1932x1910px: 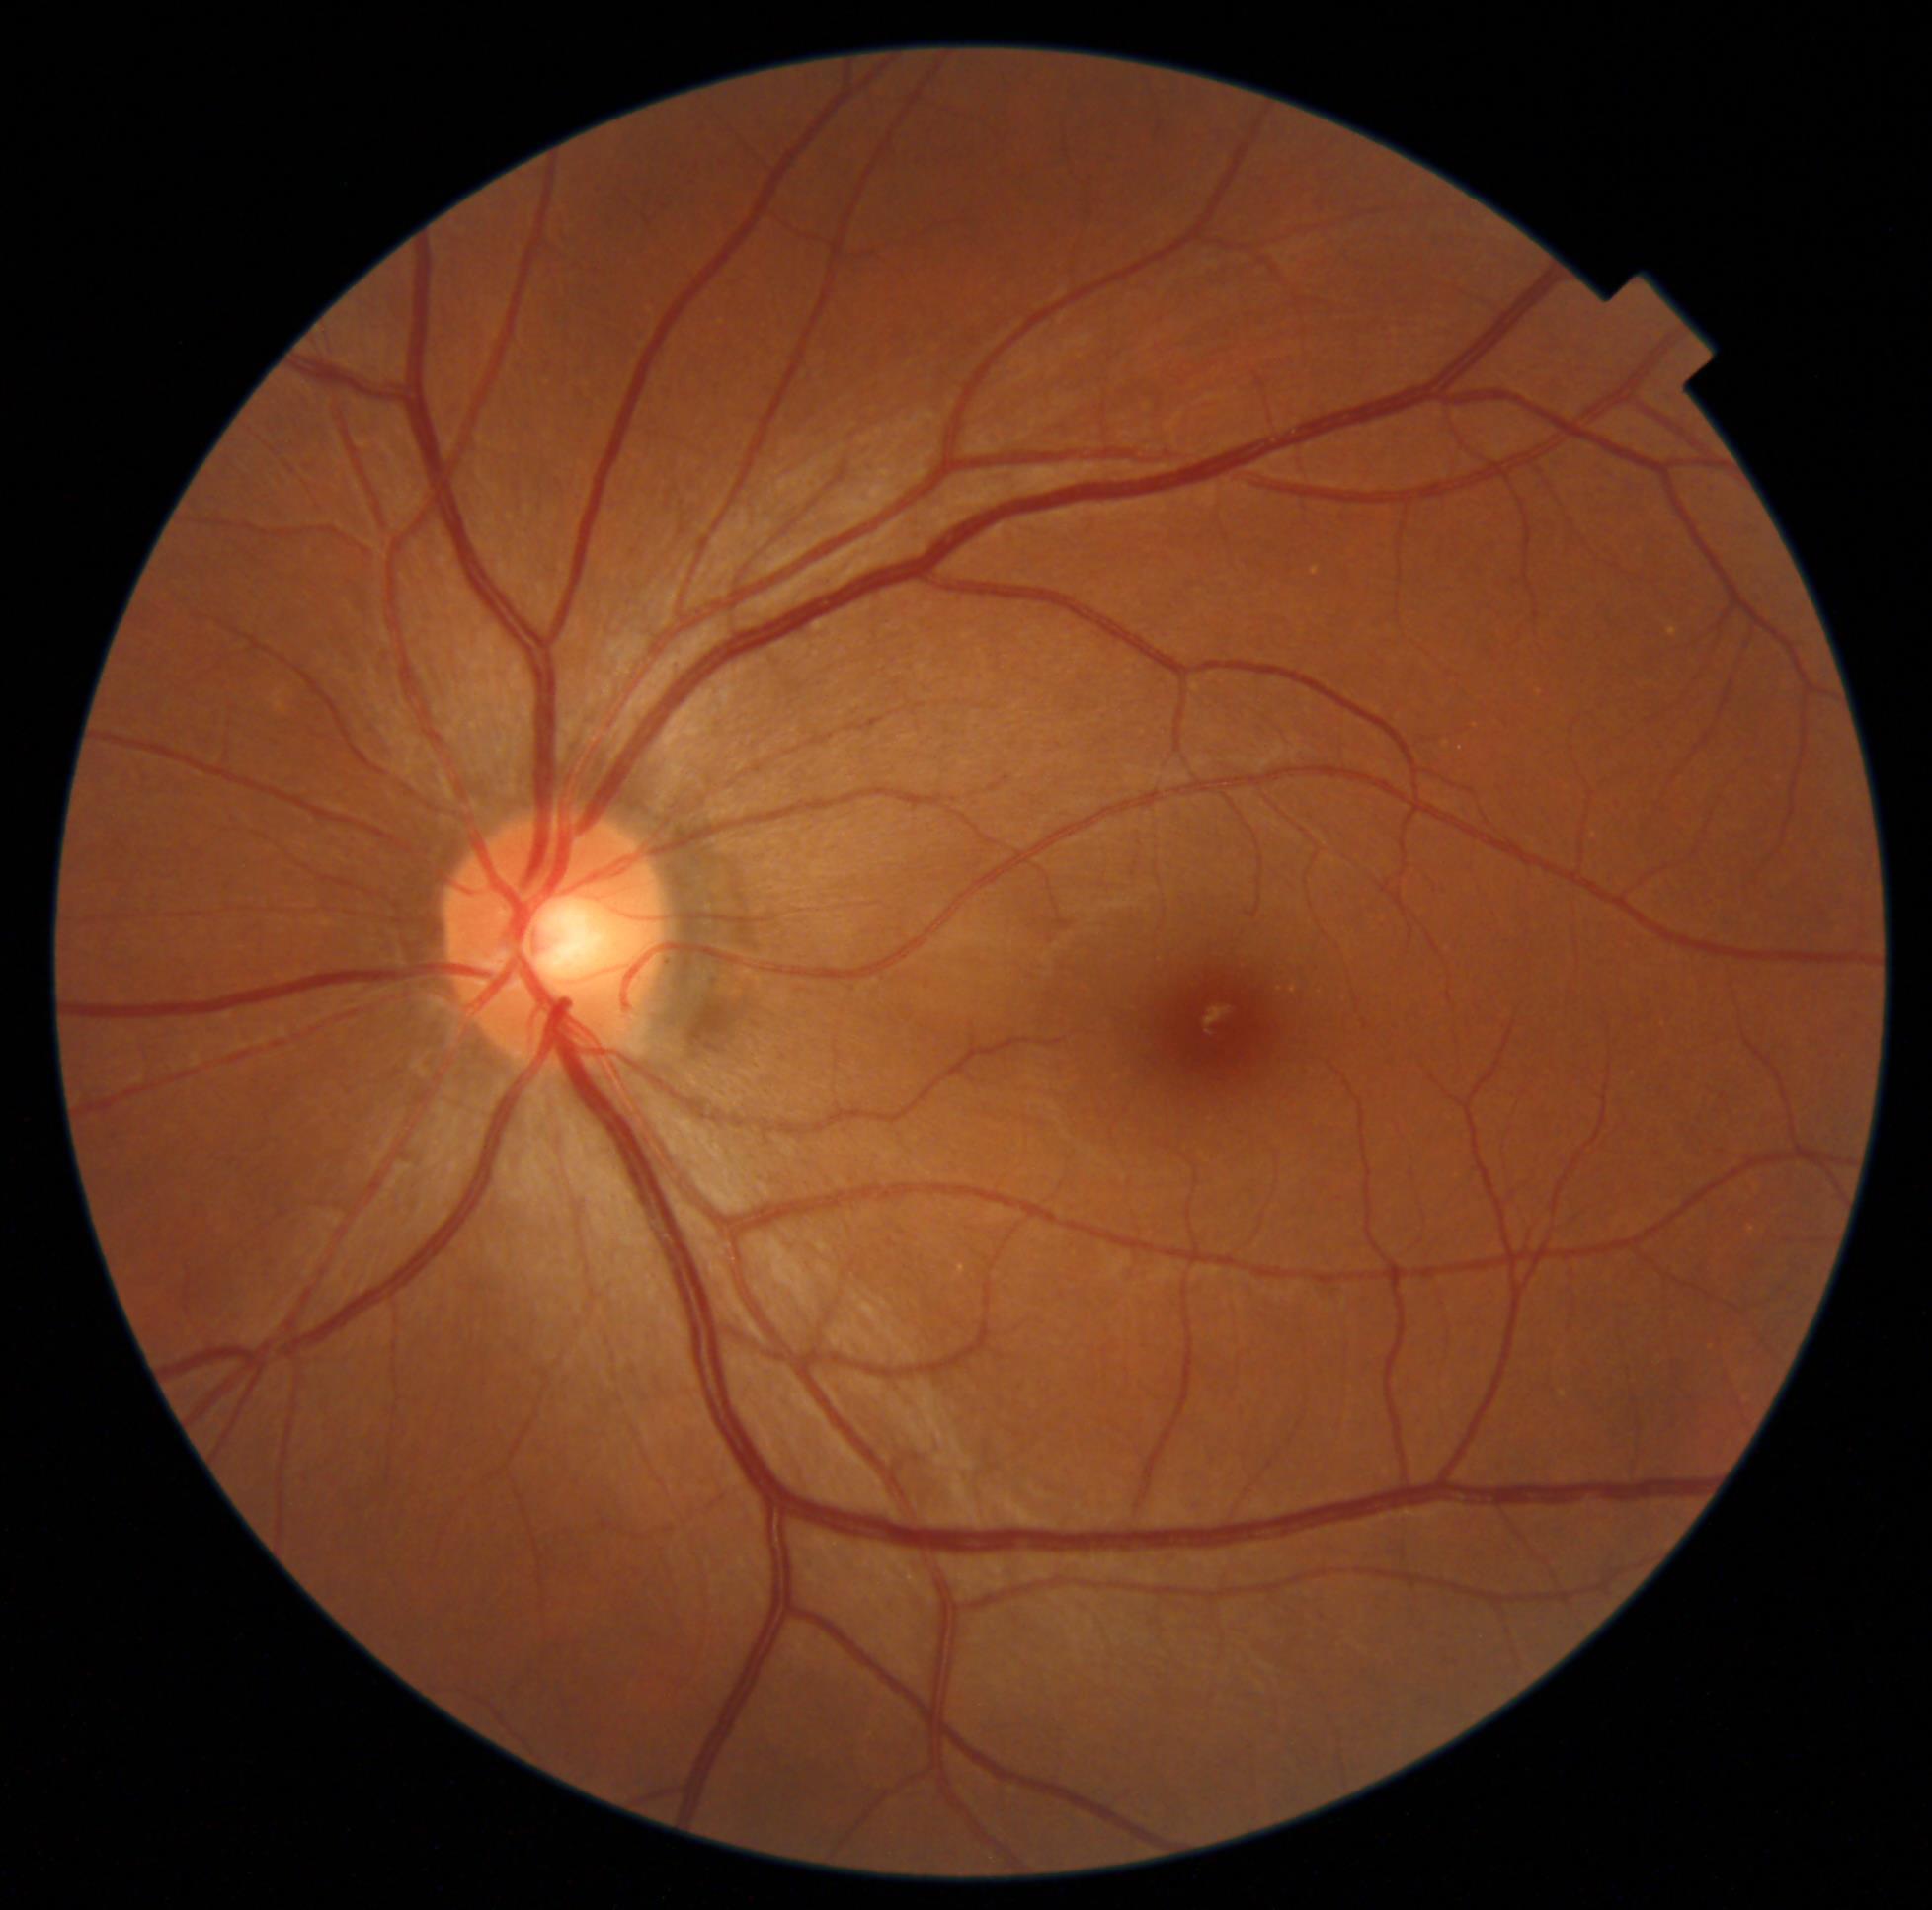 Diabetic retinopathy (DR) is grade 0 (no apparent retinopathy) — no visible signs of diabetic retinopathy.